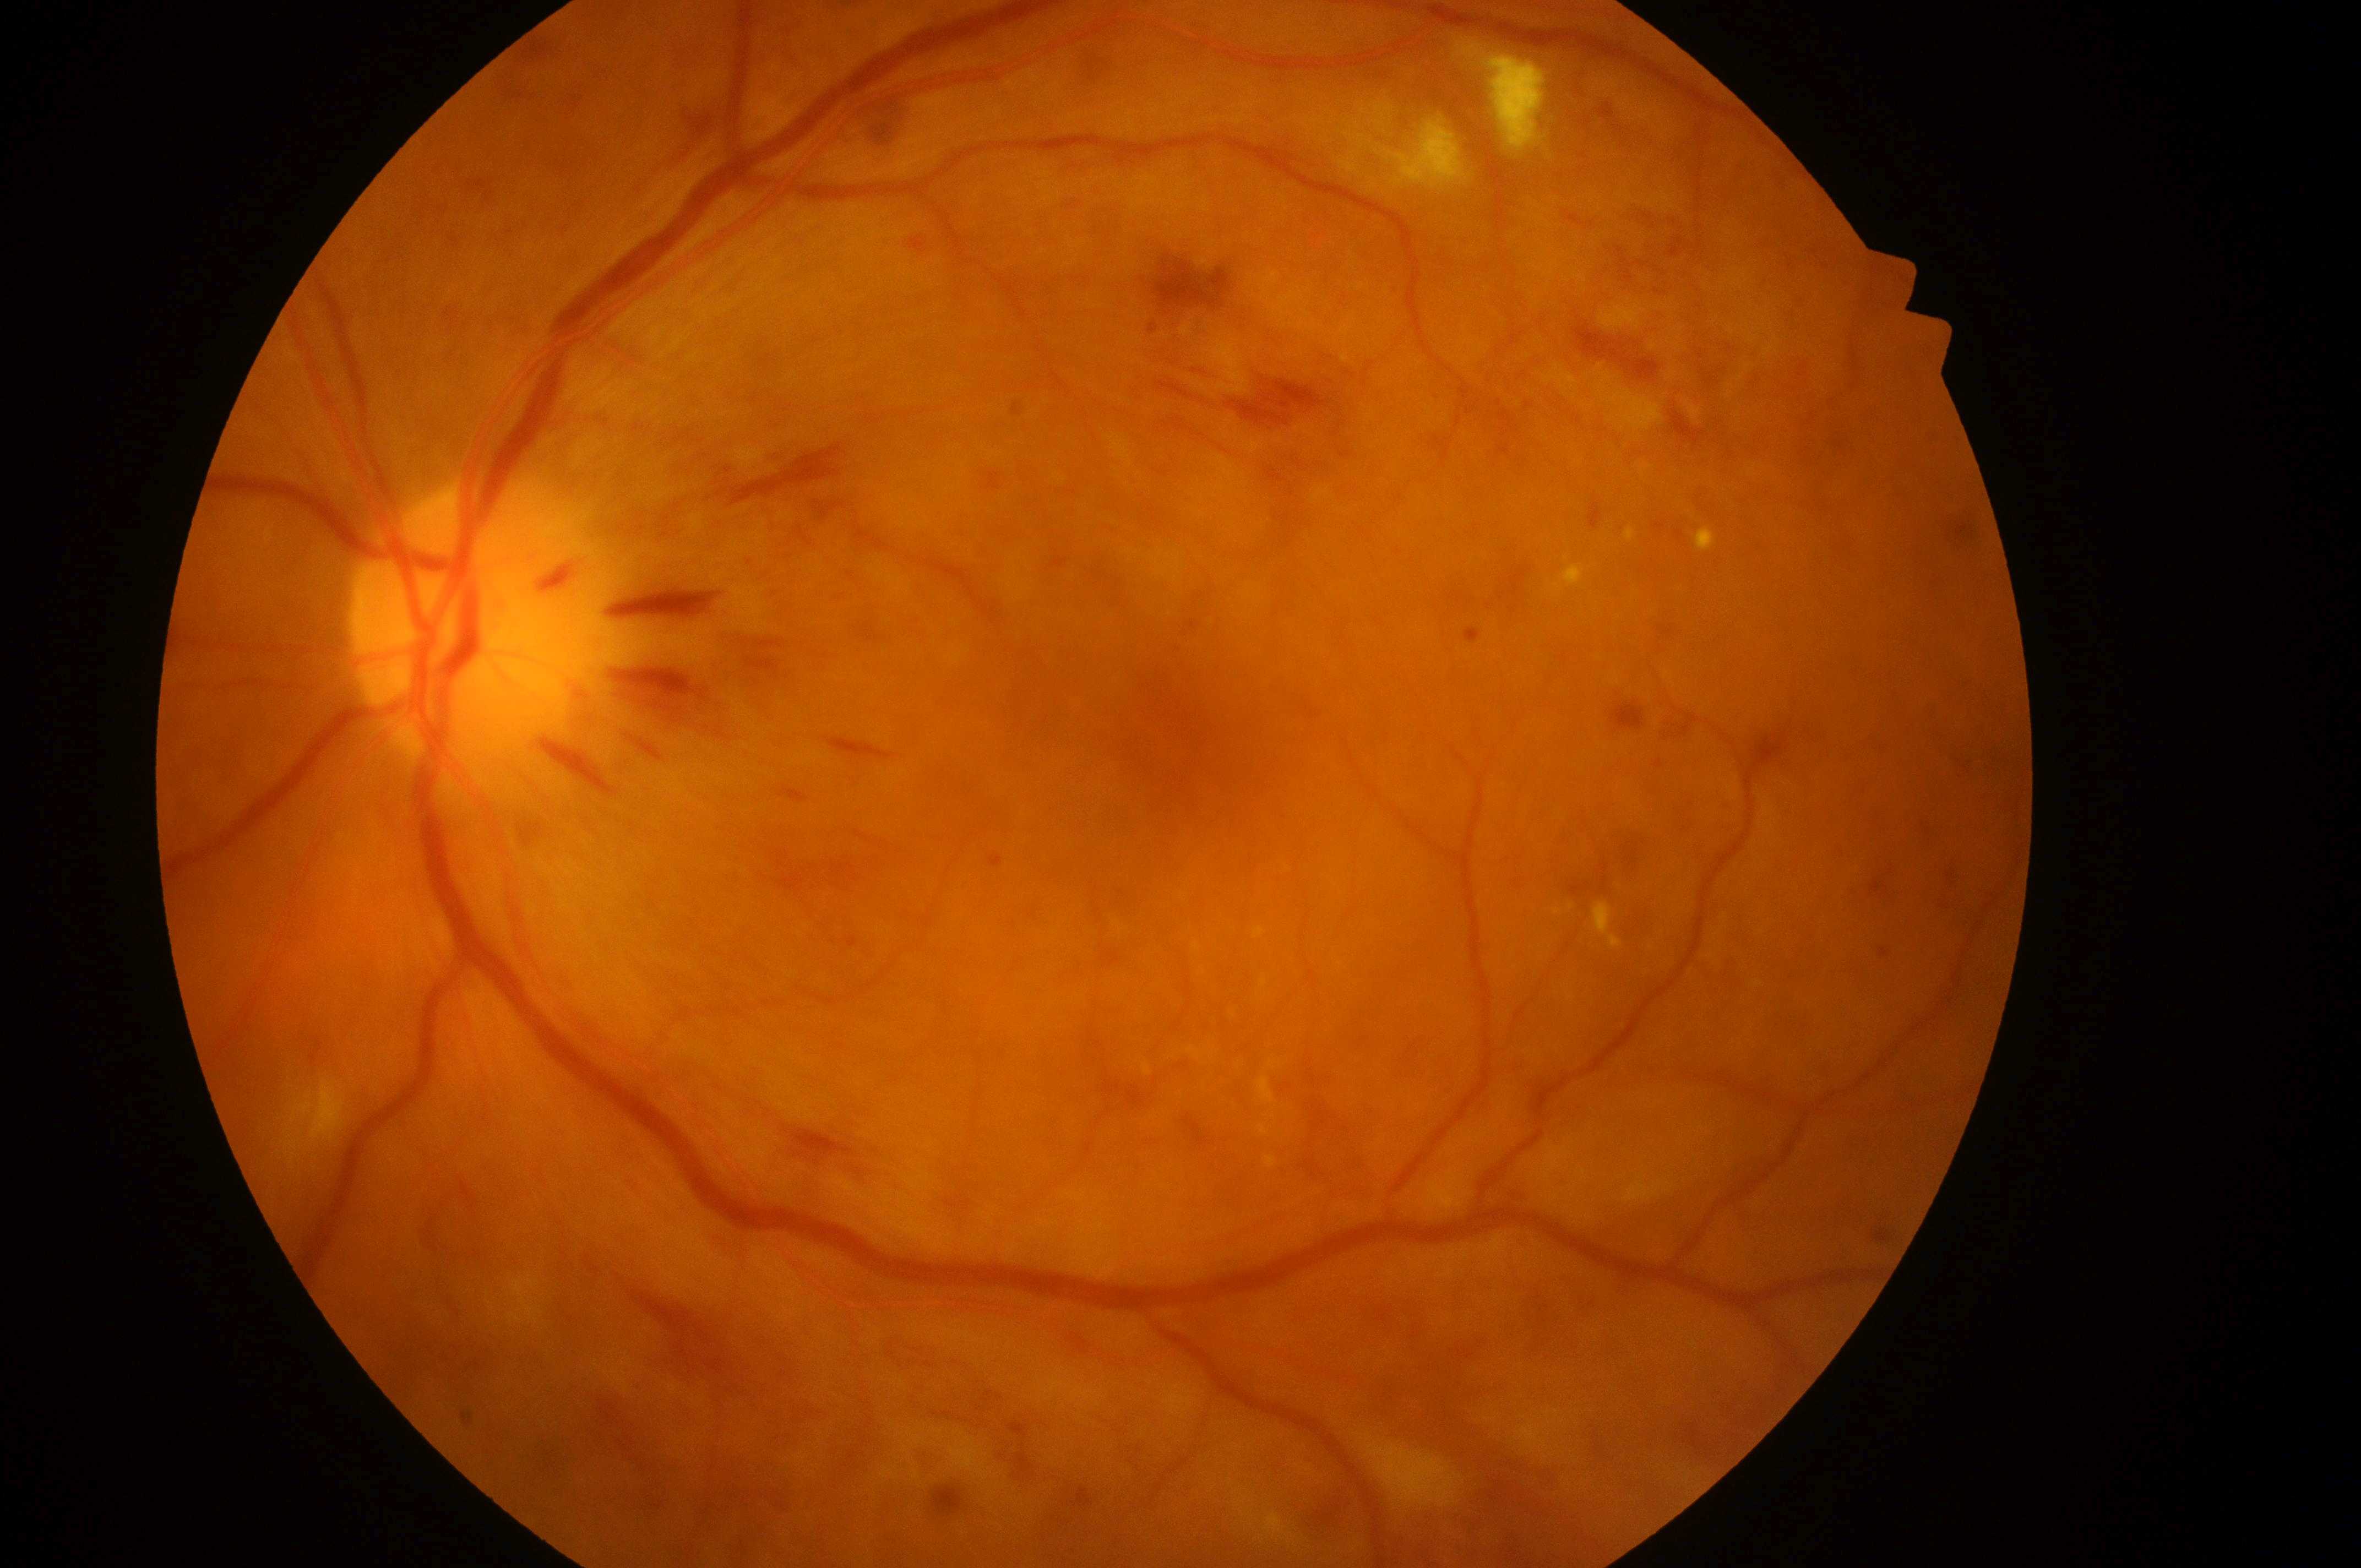
Q: Diabetic retinopathy severity?
A: grade 3 (severe NPDR)
Q: DME grade?
A: grade 2 (high risk)
Q: Where is the optic disc?
A: (468,630)
Q: Right or left eye?
A: OS
Q: Fovea center?
A: (1178,759)